45-degree field of view · 2352 x 1568 pixels:
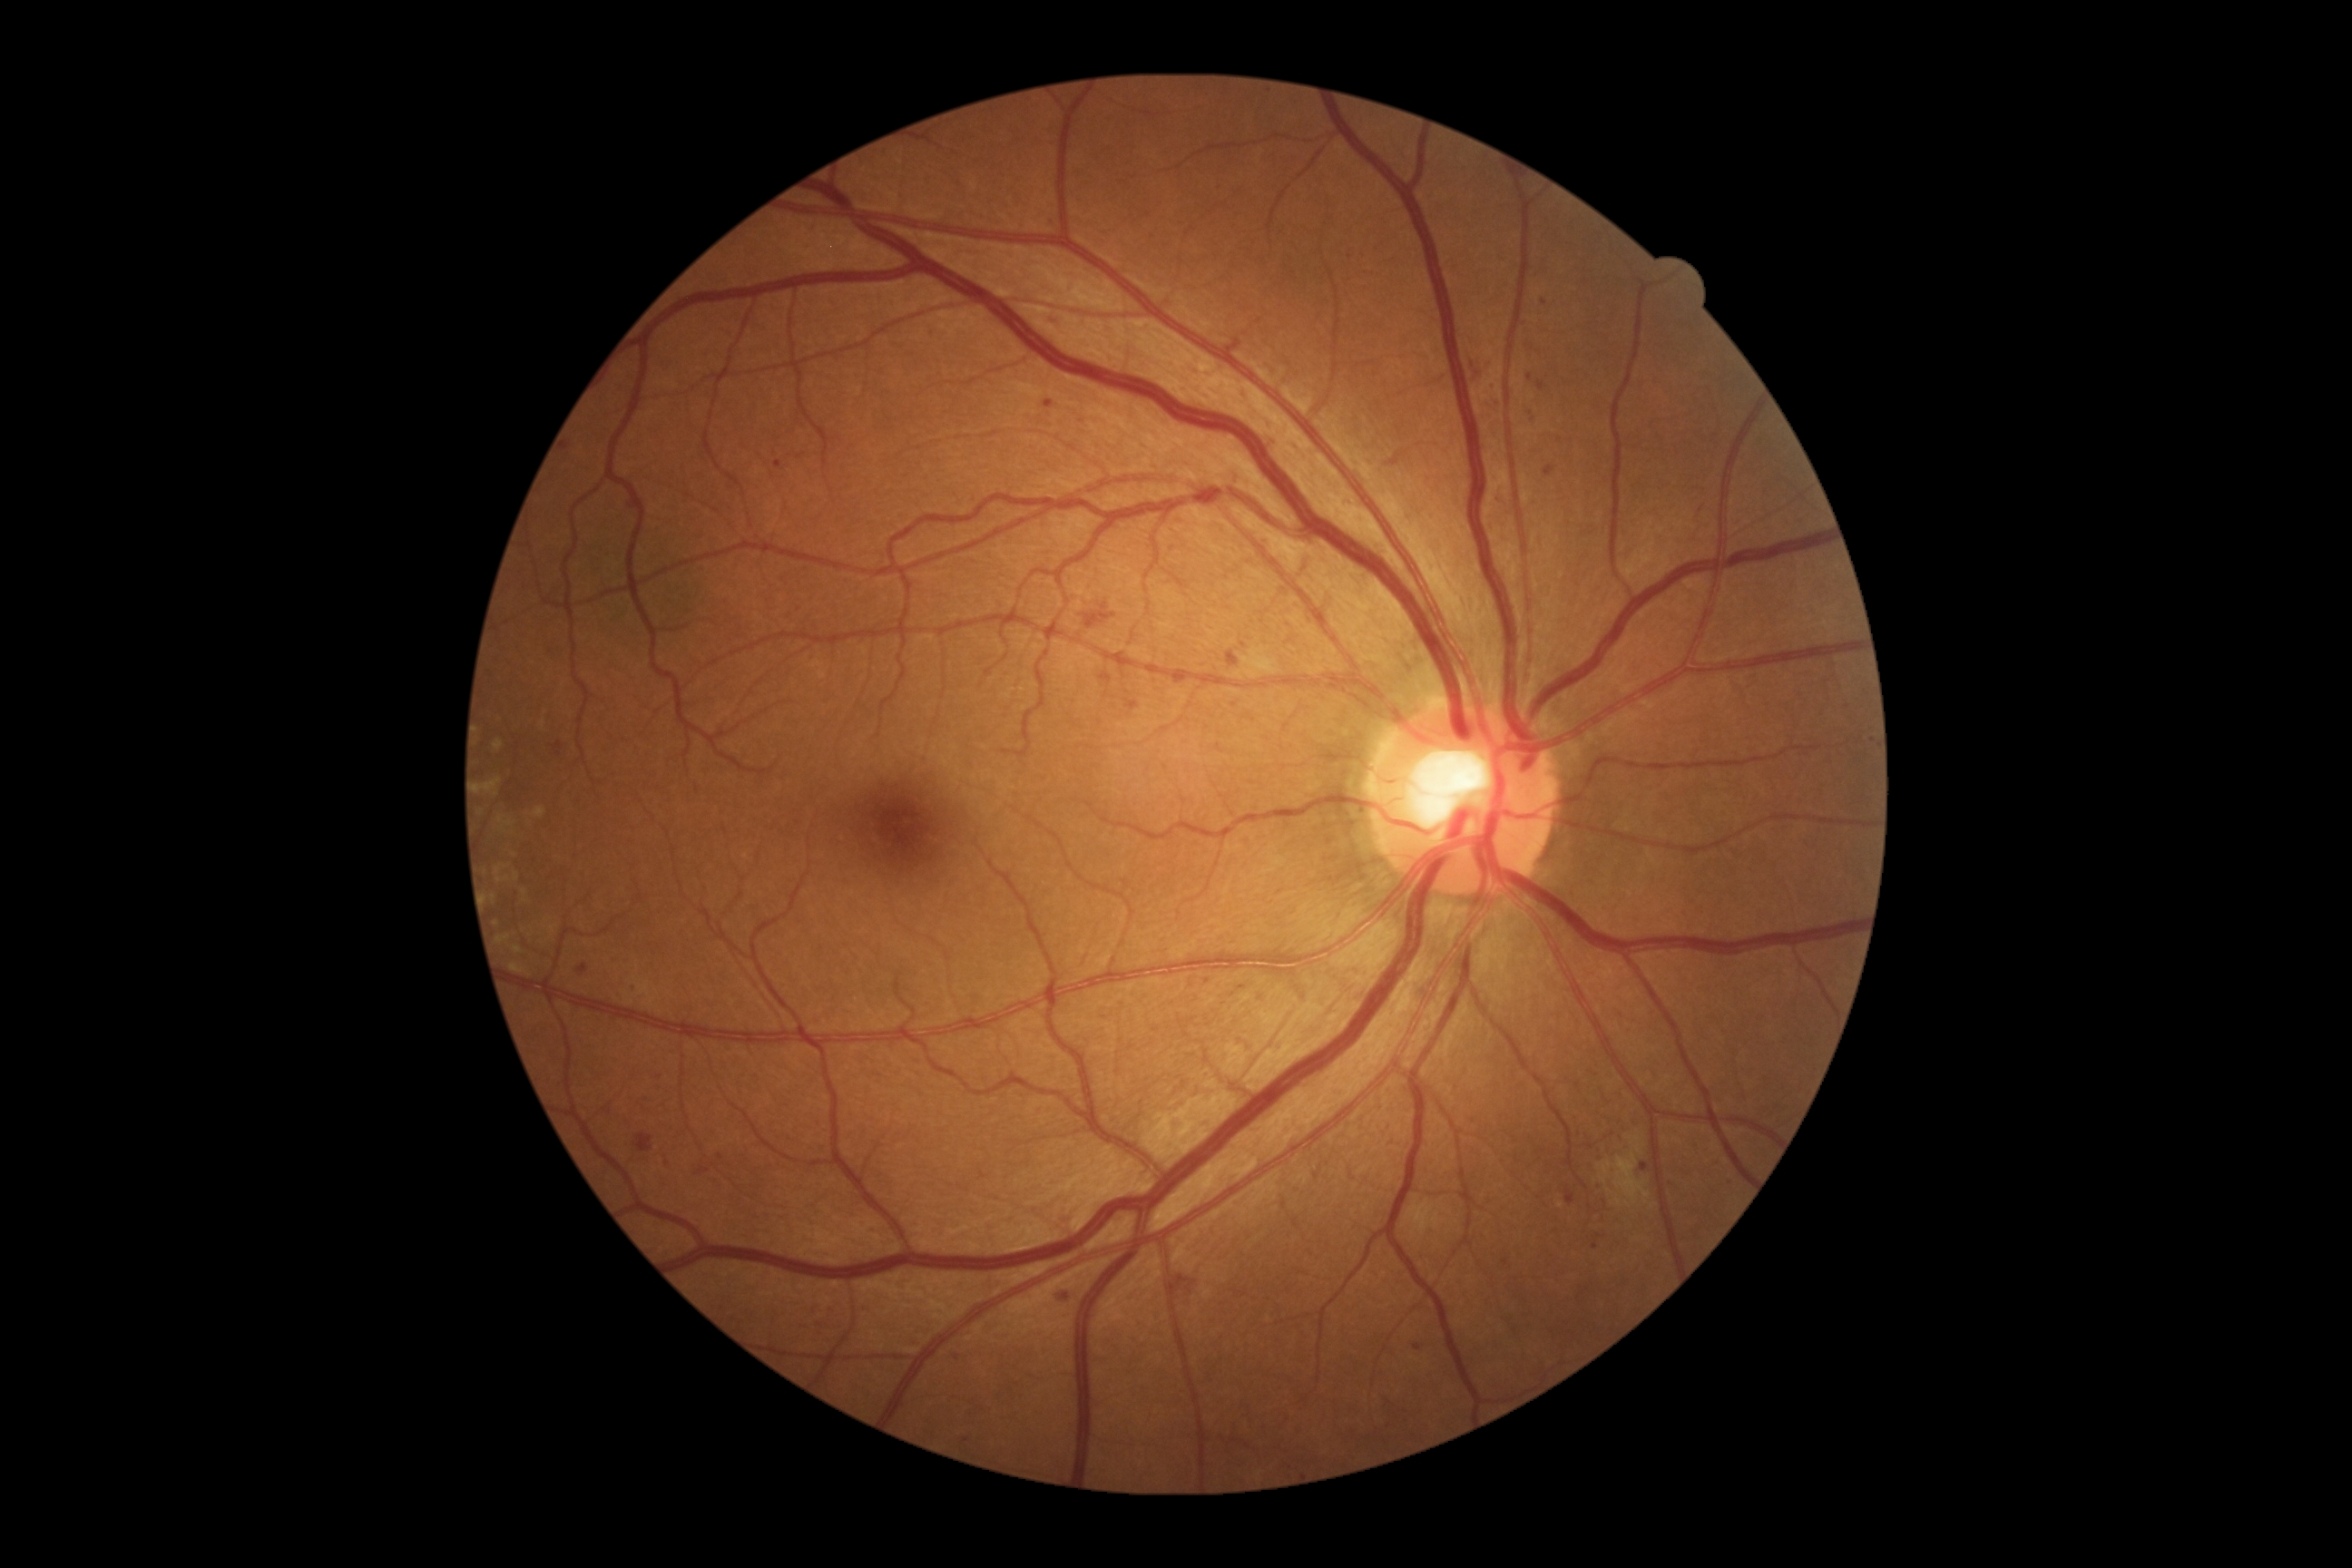
Diabetic retinopathy (DR) is grade 2
Lesions identified (partial list):
microaneurysms (MAs) (continued): [x1=629, y1=977, x2=642, y2=990] | [x1=1228, y1=651, x2=1240, y2=669] | [x1=1044, y1=400, x2=1055, y2=409] | [x1=578, y1=963, x2=589, y2=974] | [x1=1527, y1=409, x2=1536, y2=422] | [x1=774, y1=460, x2=783, y2=469] | [x1=554, y1=741, x2=564, y2=756]
Small MAs approximately at x=1506 y=1263 | x=1544 y=302 | x=1208 y=982 | x=1243 y=988 | x=1418 y=1347